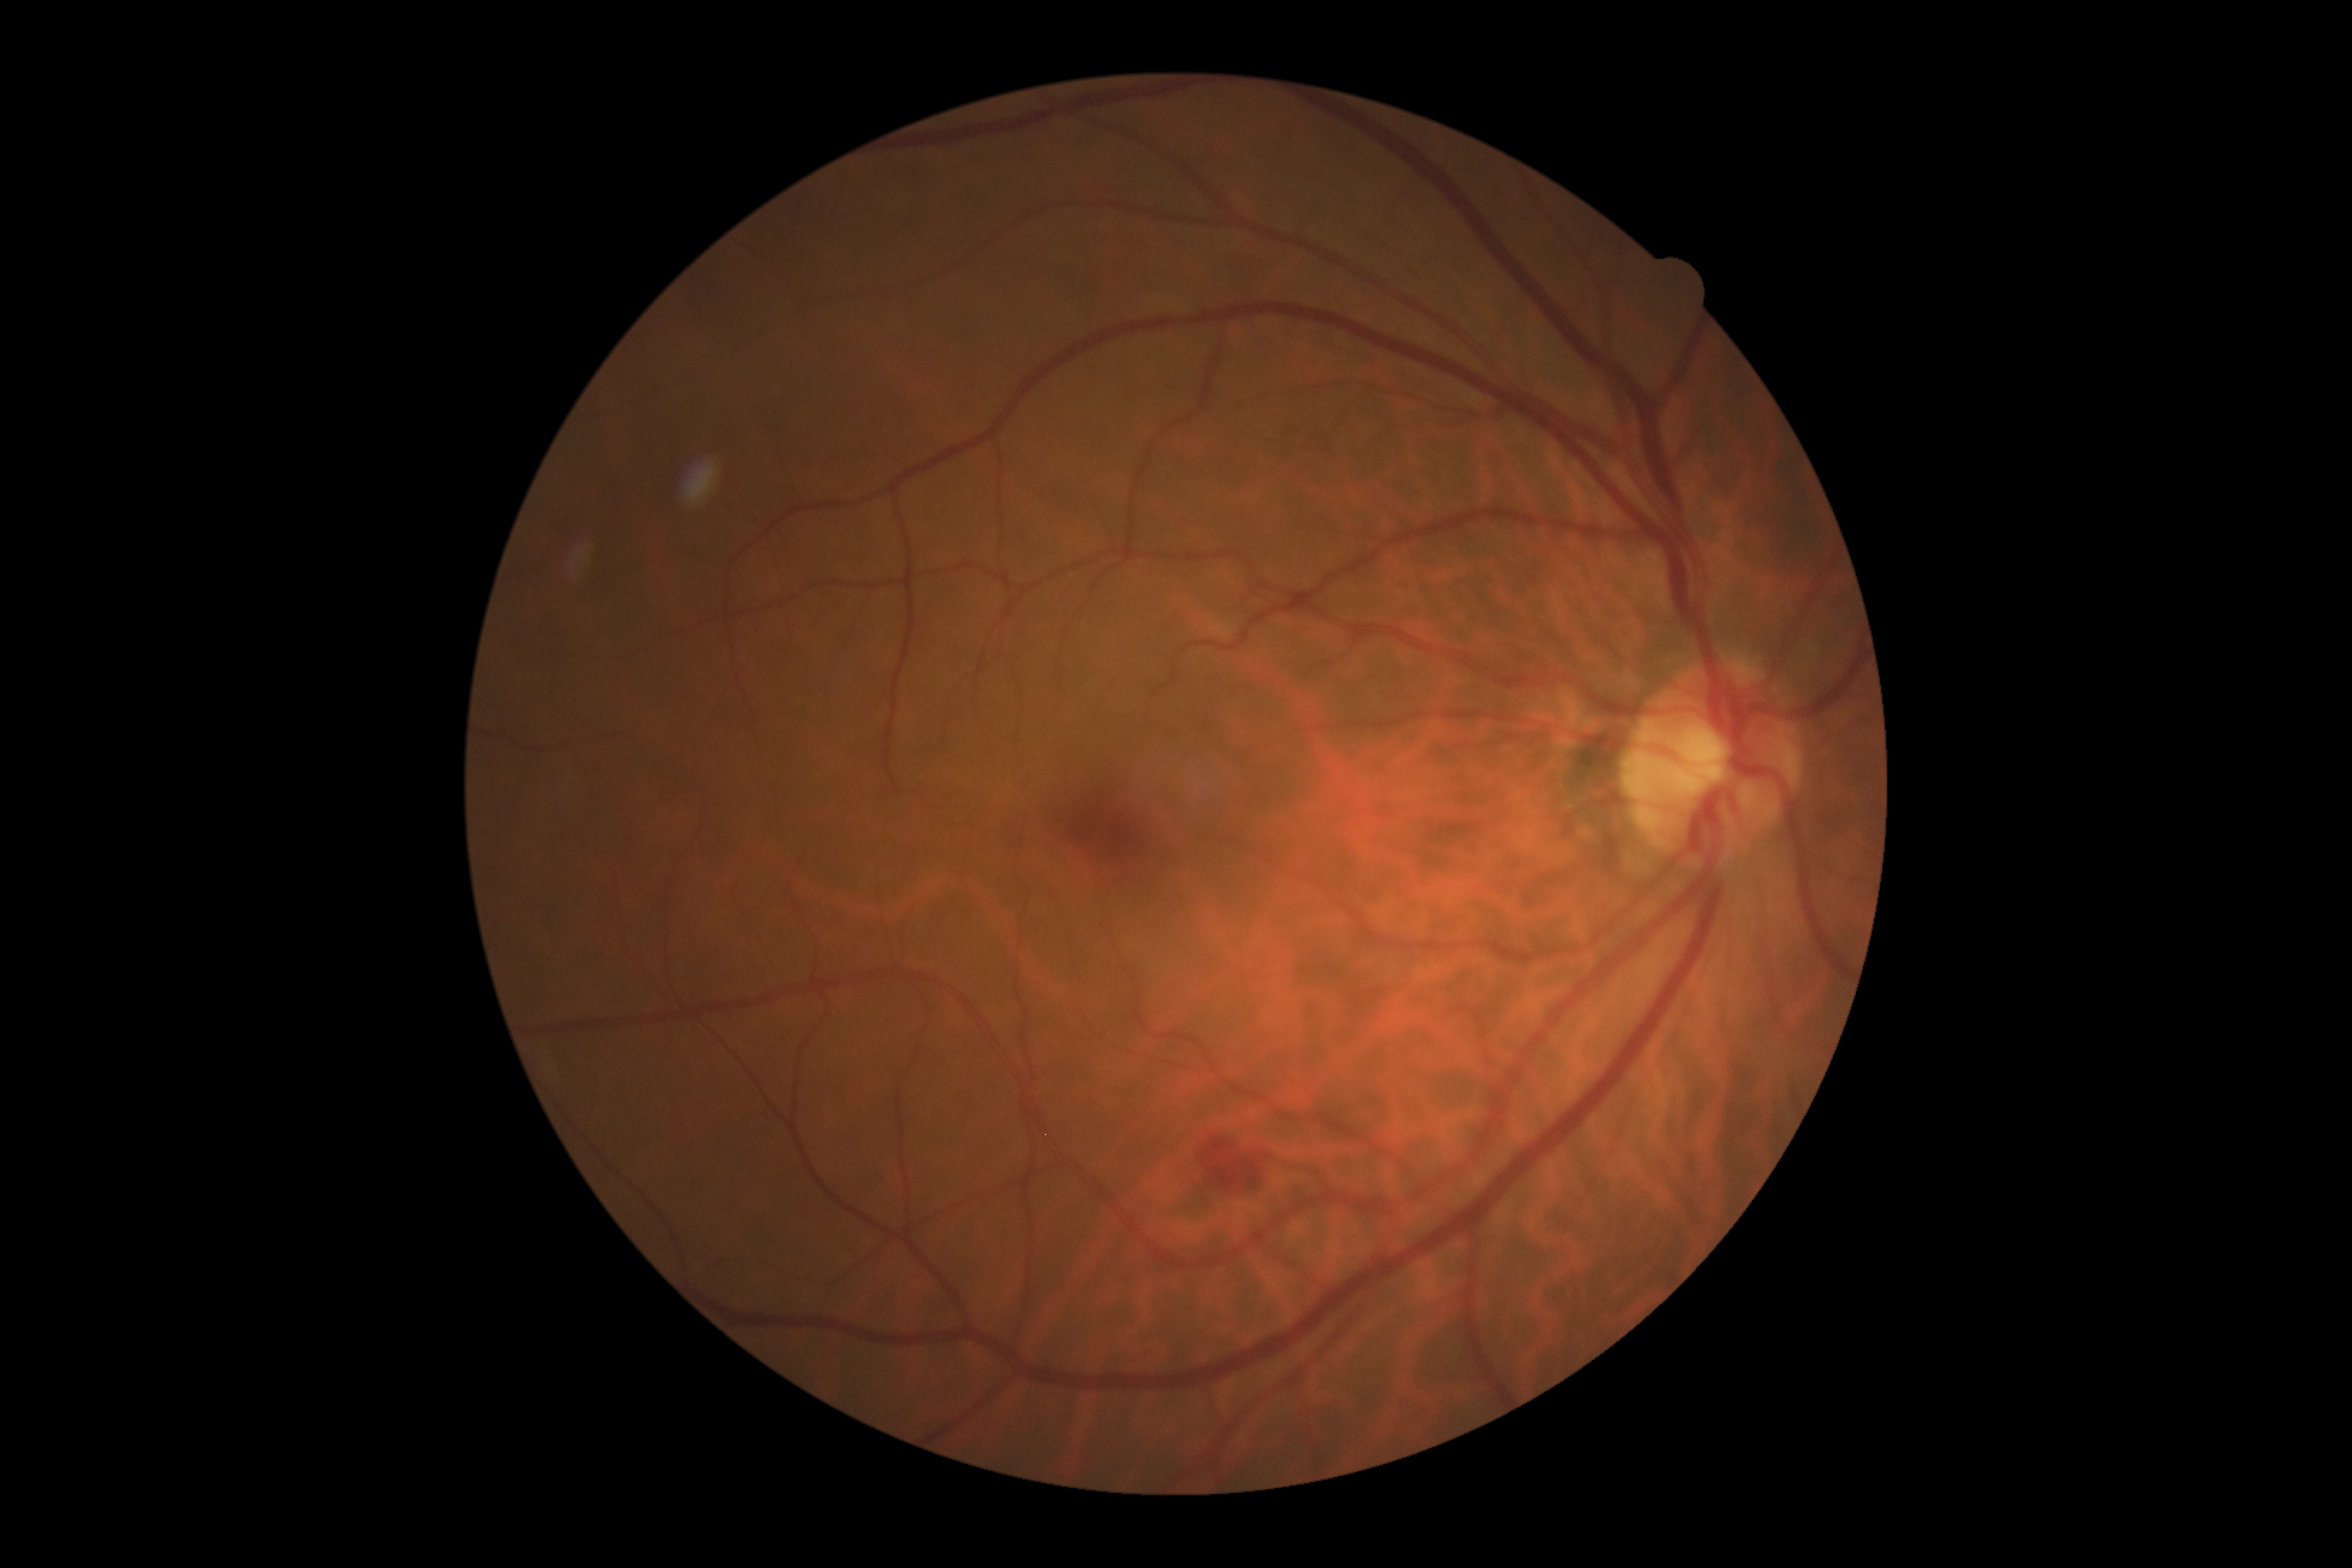

  dr_grade: moderate NPDR (grade 2)